Wide-field retinal mosaic image
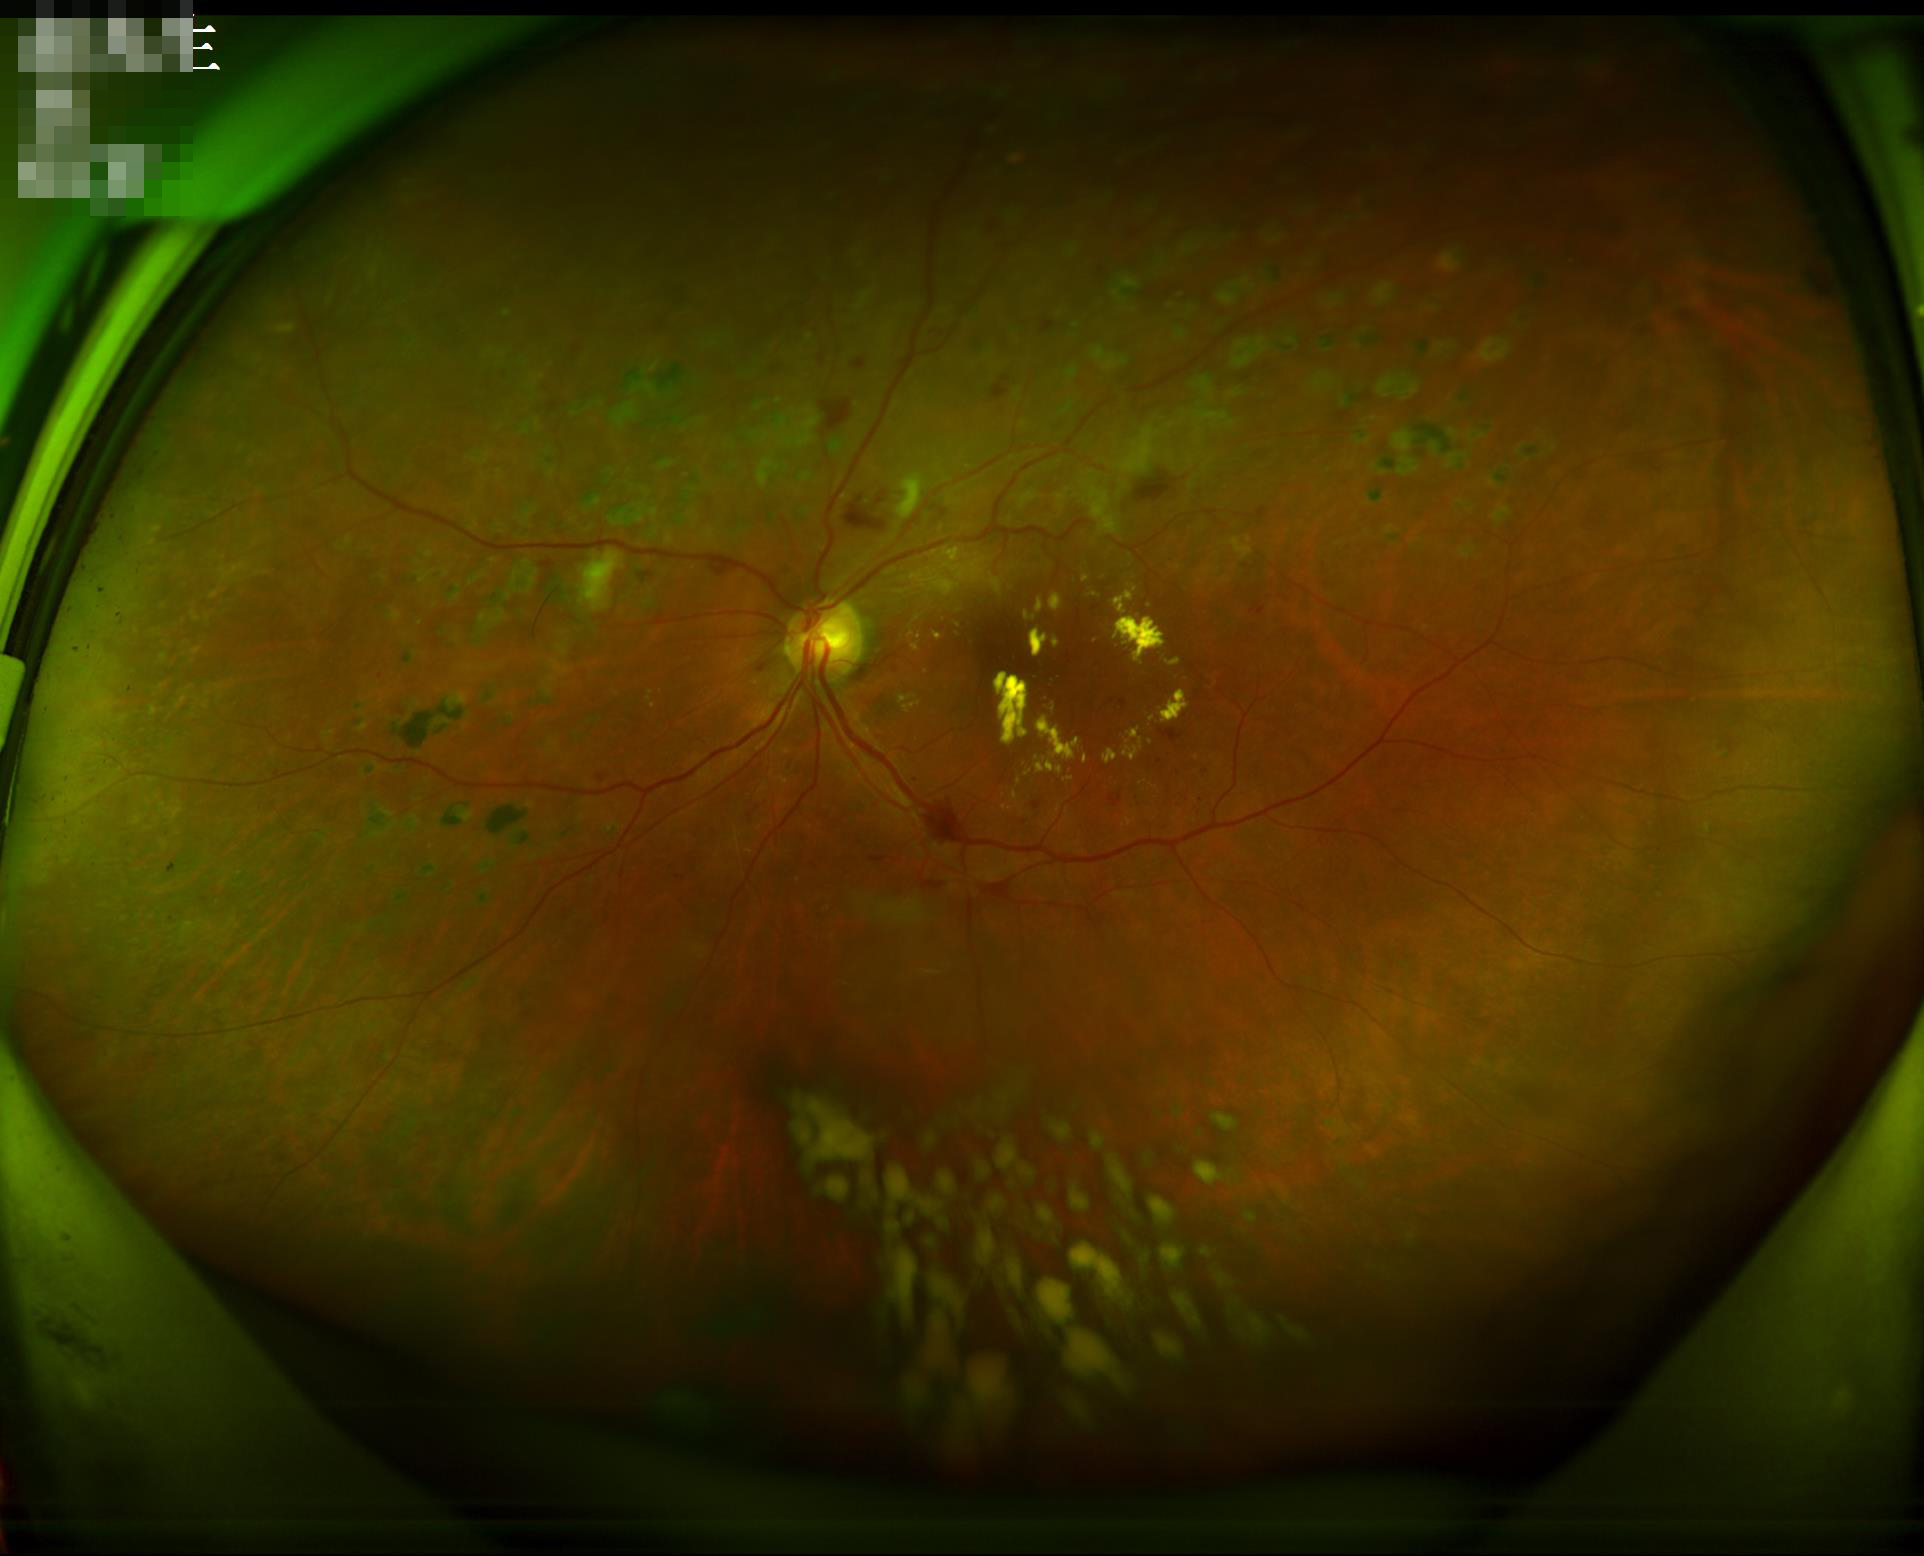 {"contrast": "good dynamic range", "illumination": "no over- or under-exposure", "overall_quality": "adequate for clinical interpretation", "clarity": "clear with no noticeable blur"}